Fundus photo · FOV: 45 degrees.
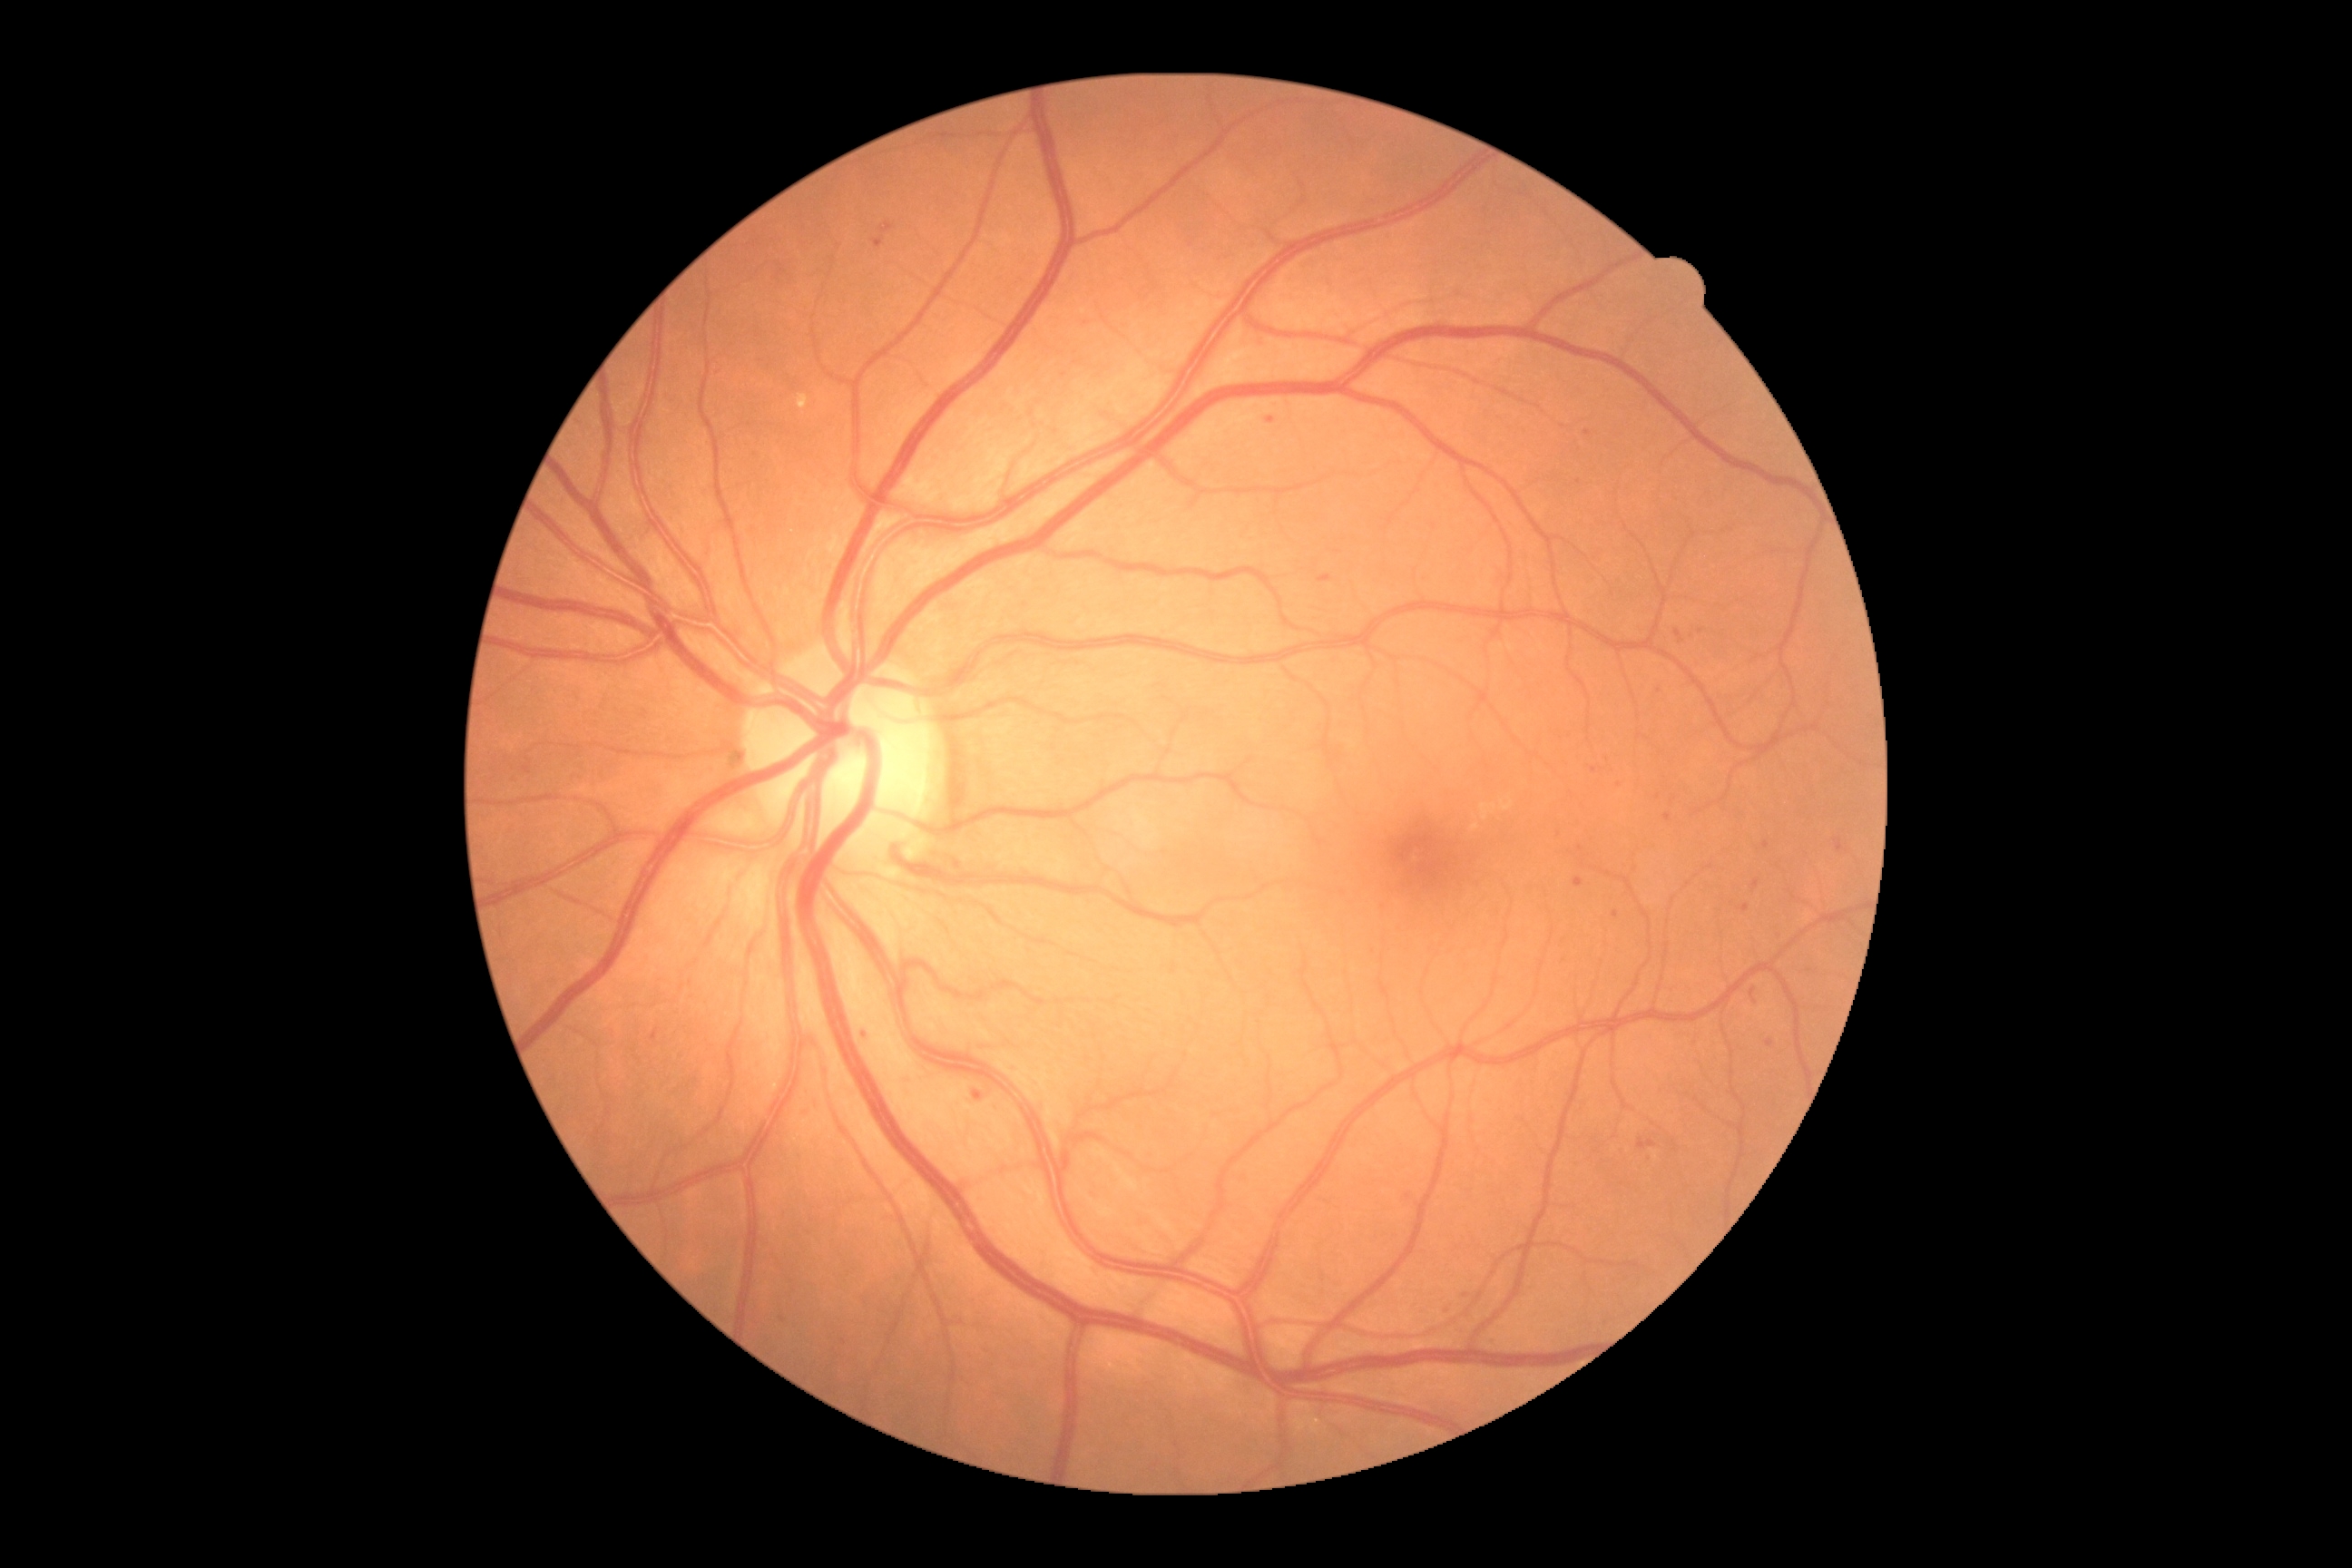
Diabetic retinopathy grade: moderate NPDR (2)
Representative lesions:
hard exudates: bbox=(798, 395, 808, 411); bbox=(1480, 805, 1498, 821); bbox=(1502, 798, 1514, 812)
Smaller hard exudates around 1476/827
microaneurysms (more not shown): bbox=(1612, 912, 1620, 919); bbox=(1752, 879, 1759, 890); bbox=(881, 226, 890, 231); bbox=(1674, 629, 1683, 634); bbox=(874, 239, 883, 250); bbox=(1574, 877, 1583, 888)
Smaller microaneurysms around 1651/1156; 1701/631; 1595/770; 783/1319; 1770/1043; 1466/1295; 865/1036; 1683/642
soft exudates: none
hemorrhages: bbox=(1749, 988, 1758, 1004); bbox=(1318, 574, 1333, 583)